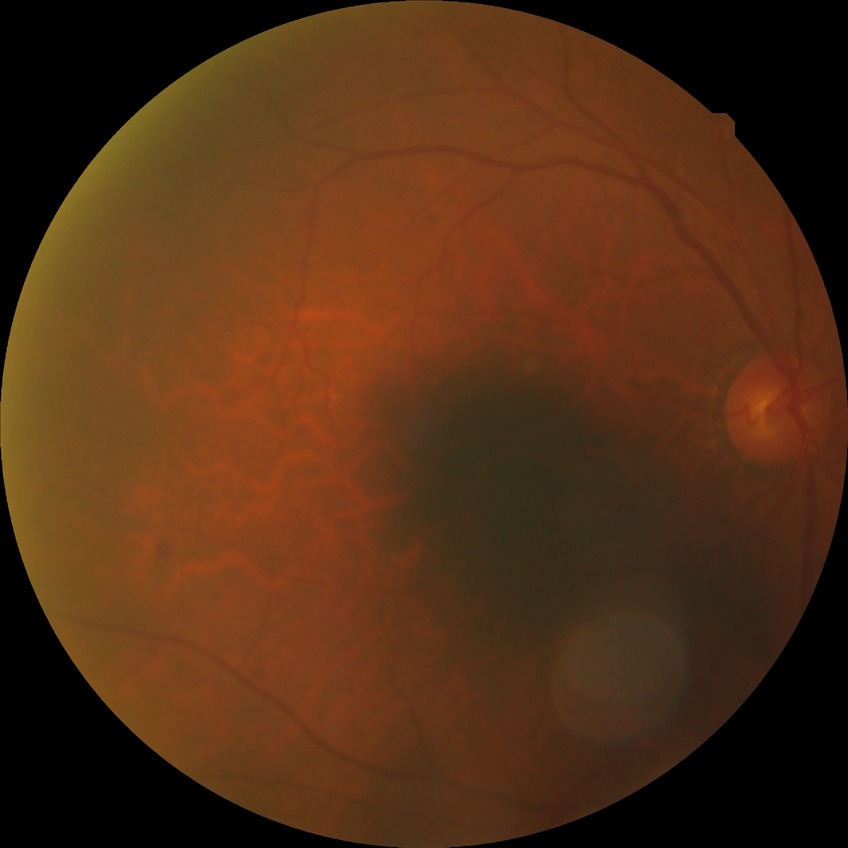
davis_grade: SDR
proliferative_class: non-proliferative diabetic retinopathy